Retinal fundus photograph; without pupil dilation; 848 x 848 pixels; 45-degree field of view.
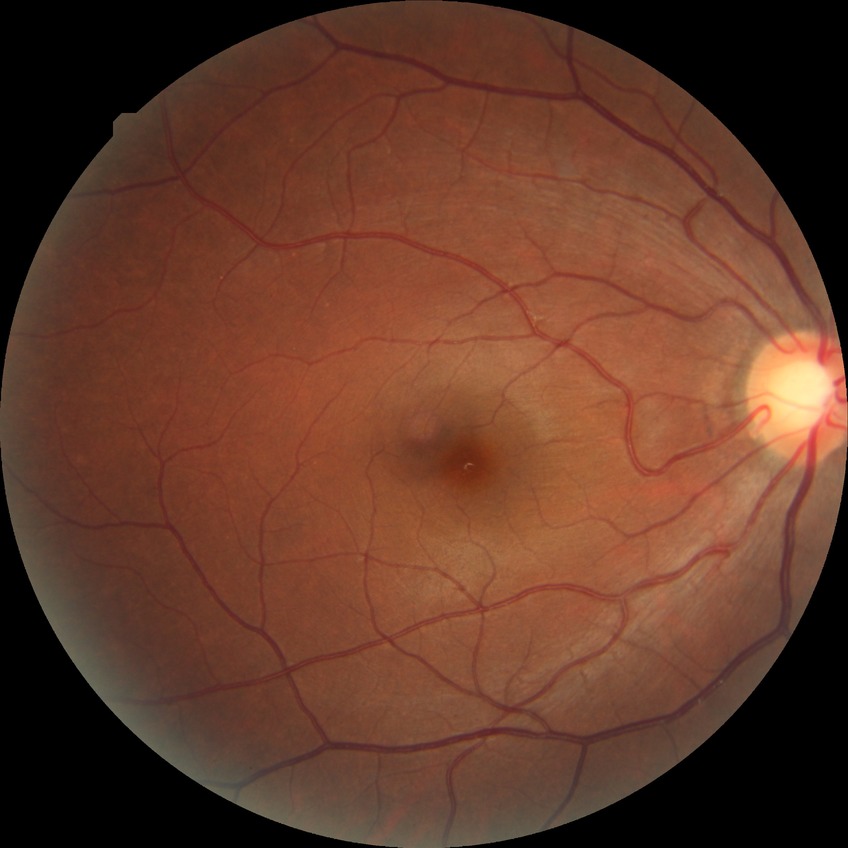 Modified Davis classification is no diabetic retinopathy.